2212 x 1659 pixels; 45-degree field of view.
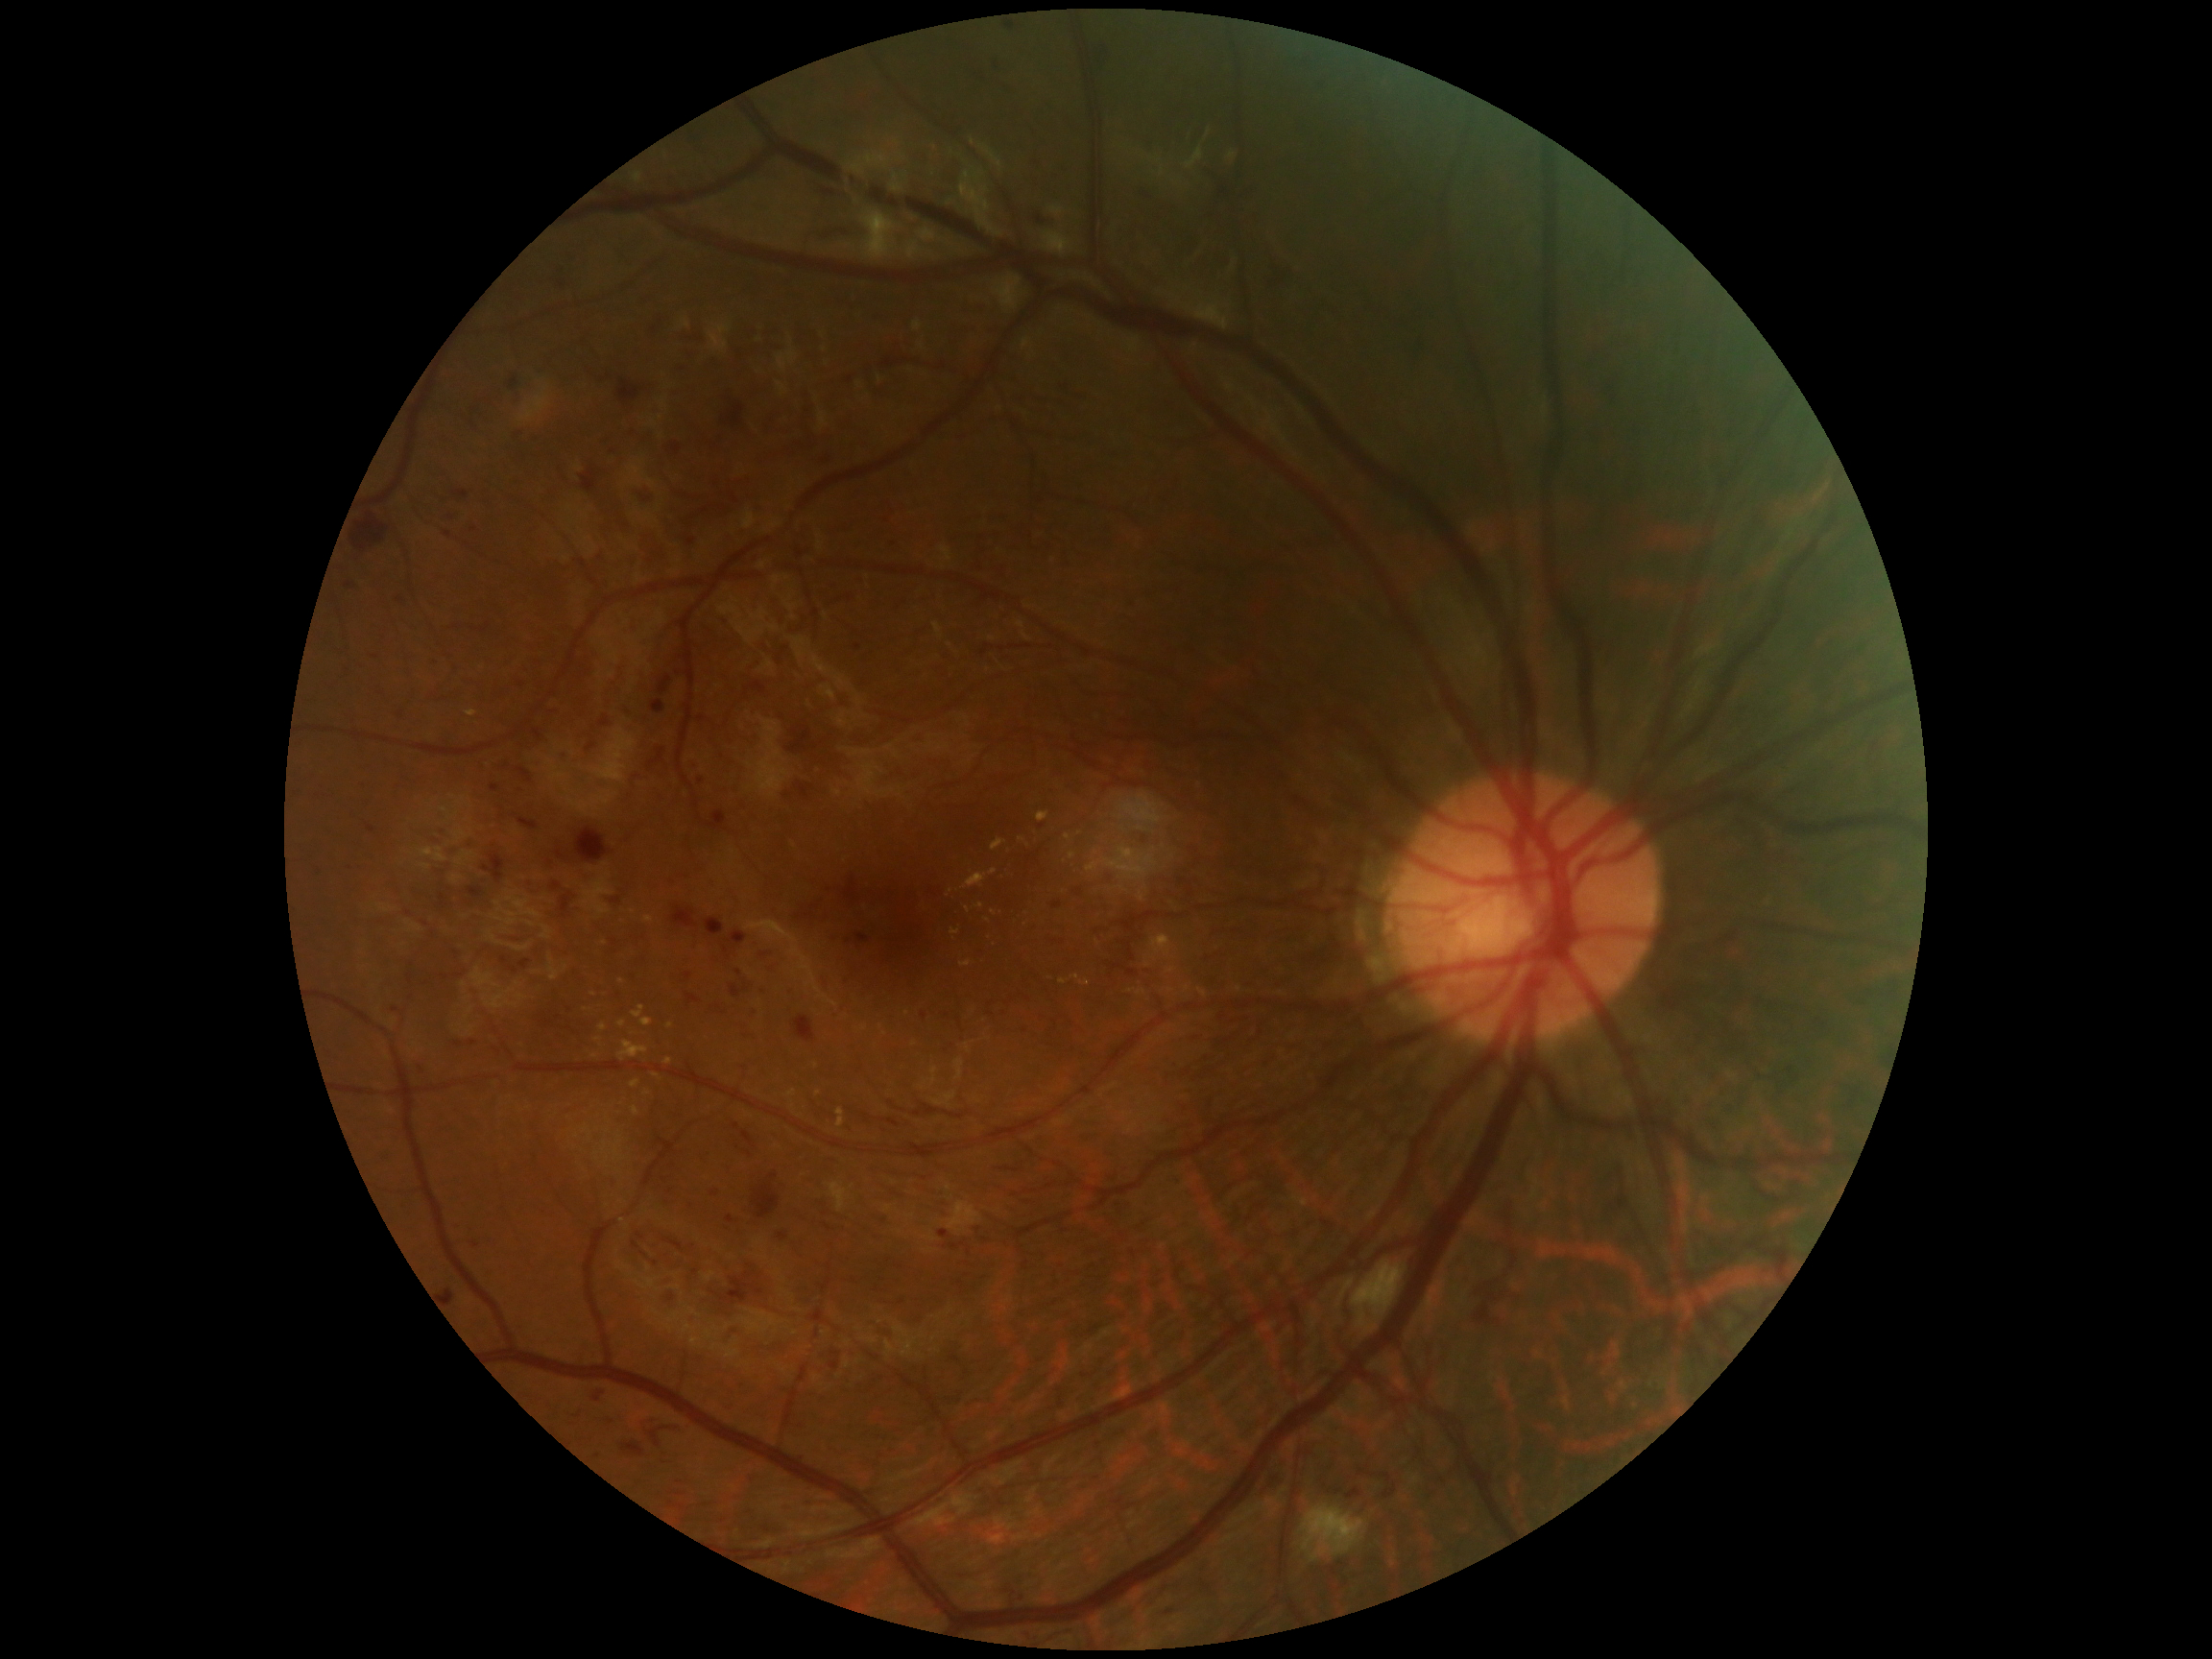 Annotations:
• DR: severe NPDR (grade 3)